Image size 1504x1000.
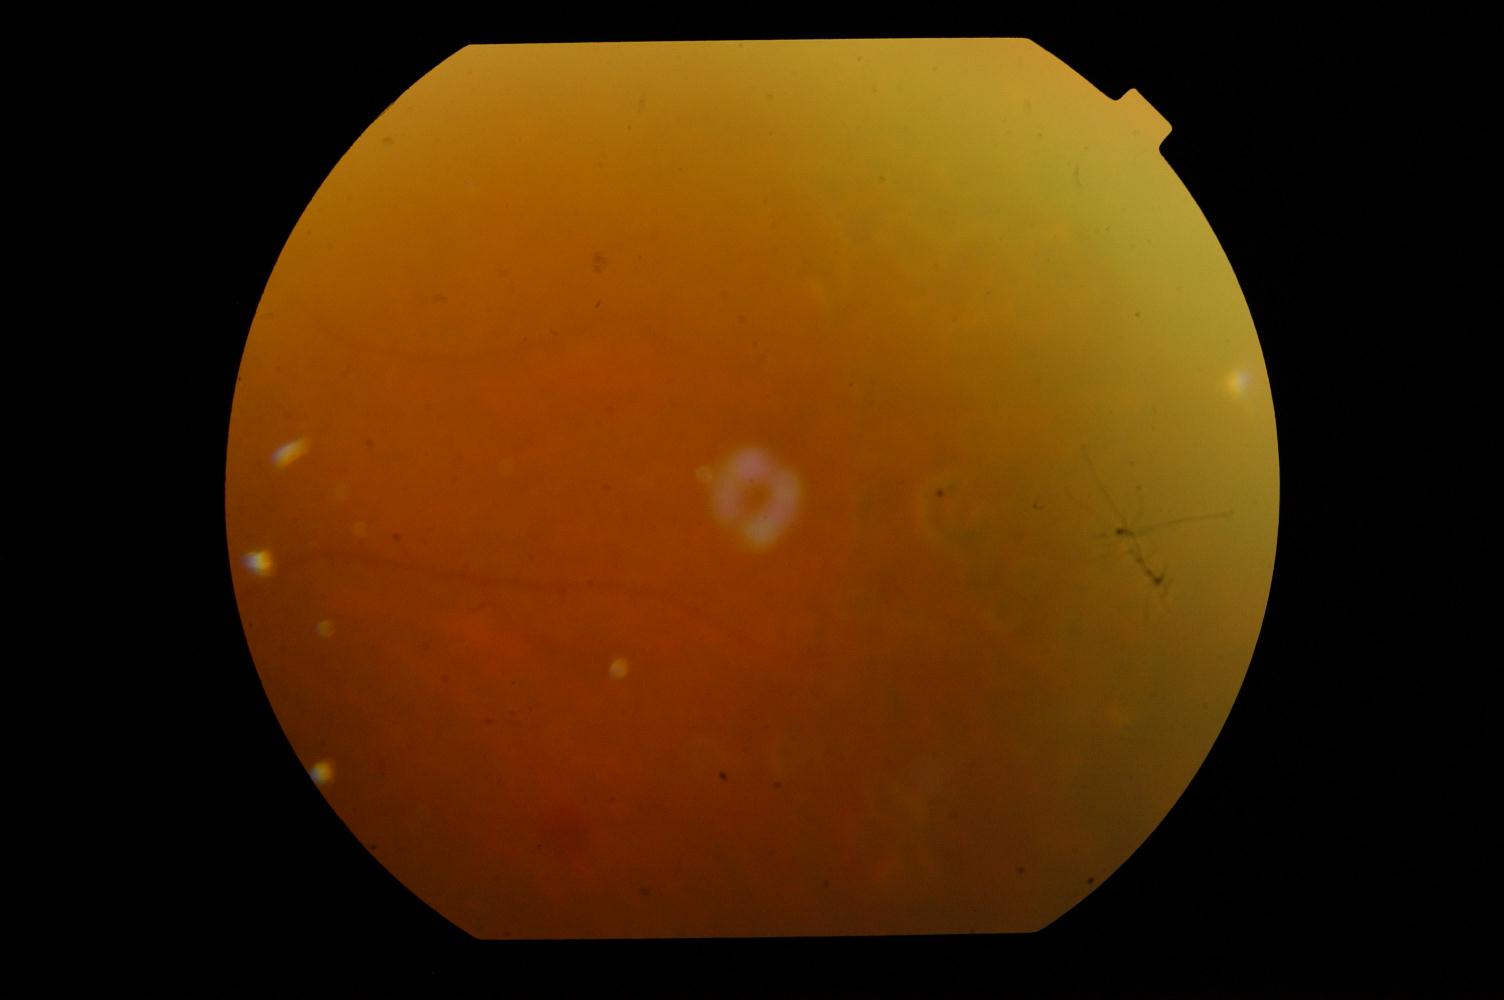
Findings: diabetic retinopathy (DR).